Color fundus photograph from a handheld portable camera · FOV: 60 degrees
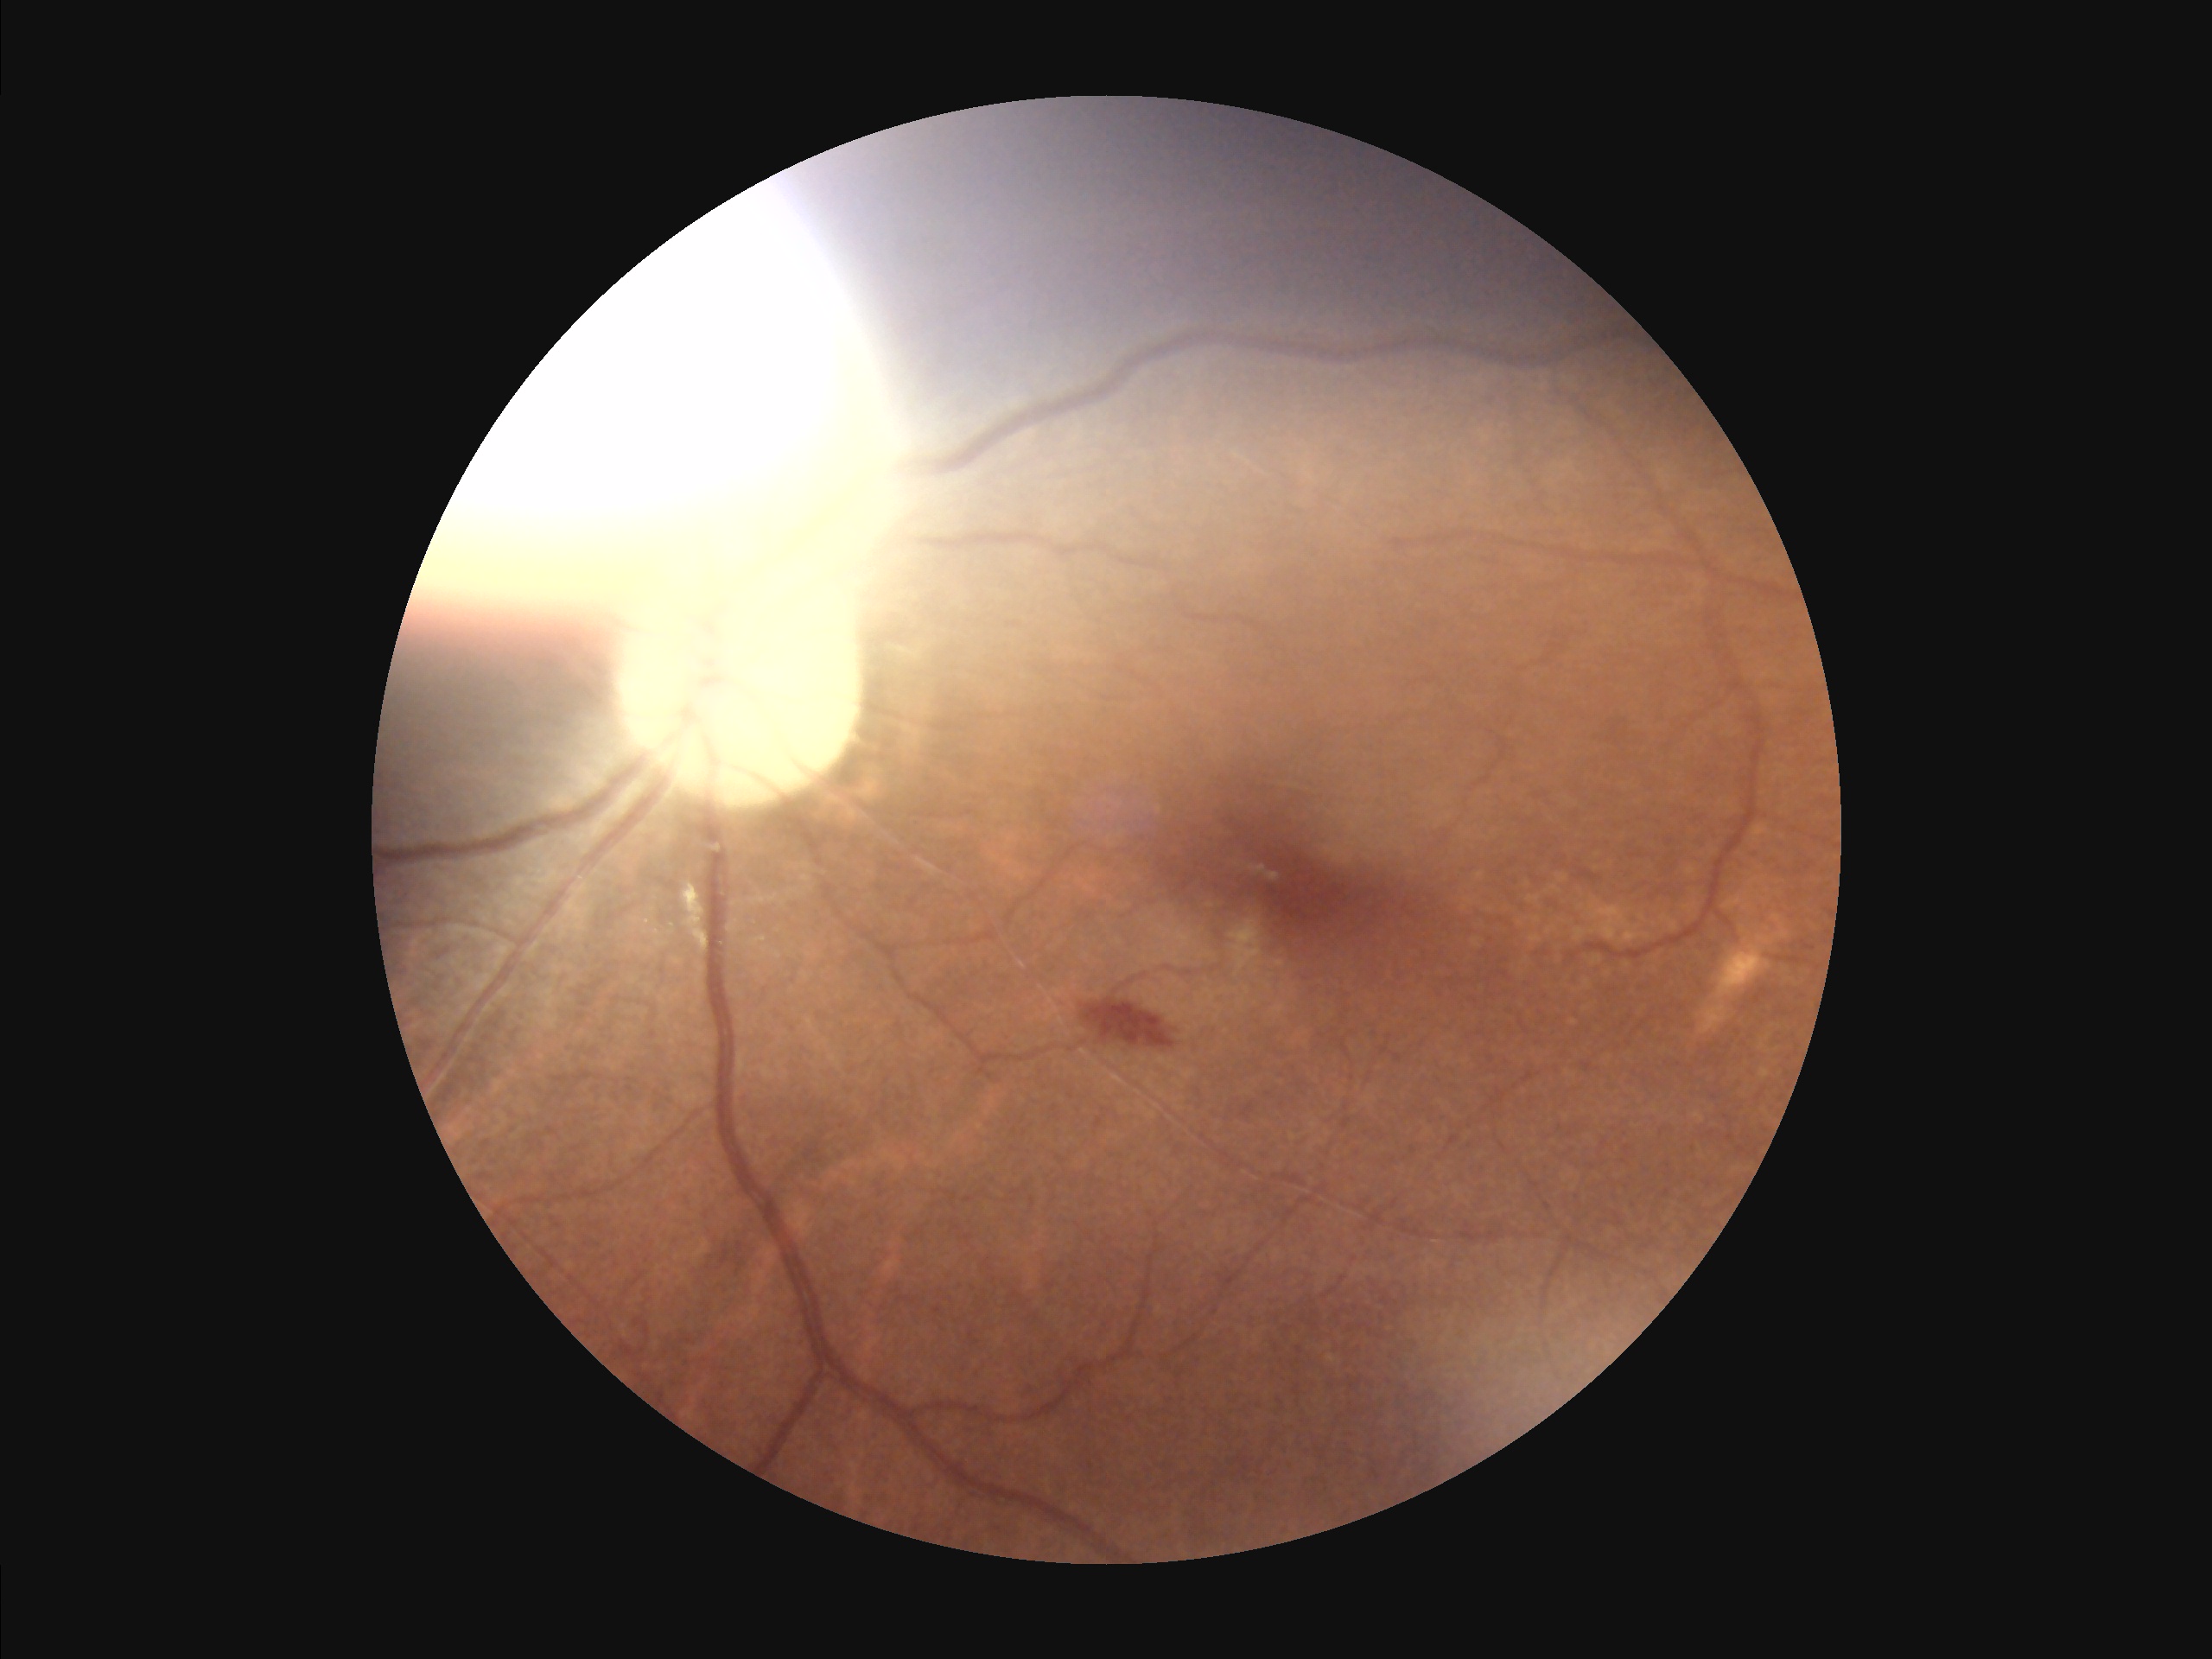 contrast: adequate
overall_quality: inadequate
illumination: poor
clarity: sharp